Color fundus photograph — 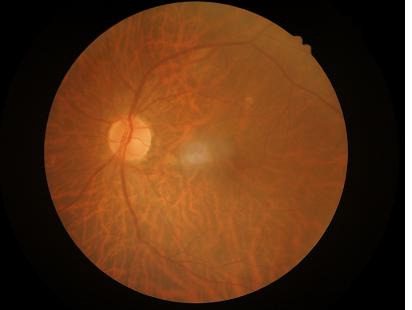 Image quality is adequate for diagnostic use. Vessels and details are readily distinguishable. Image is sharp throughout the field. Even illumination with no color cast.